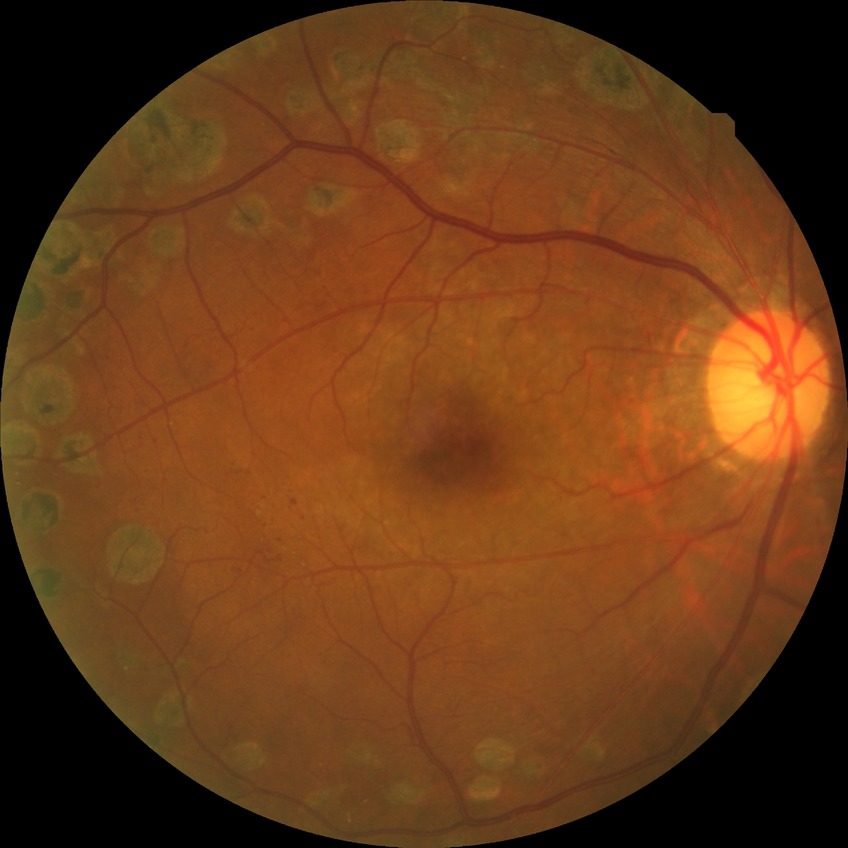 Diabetic retinopathy (DR) is PDR (proliferative diabetic retinopathy).